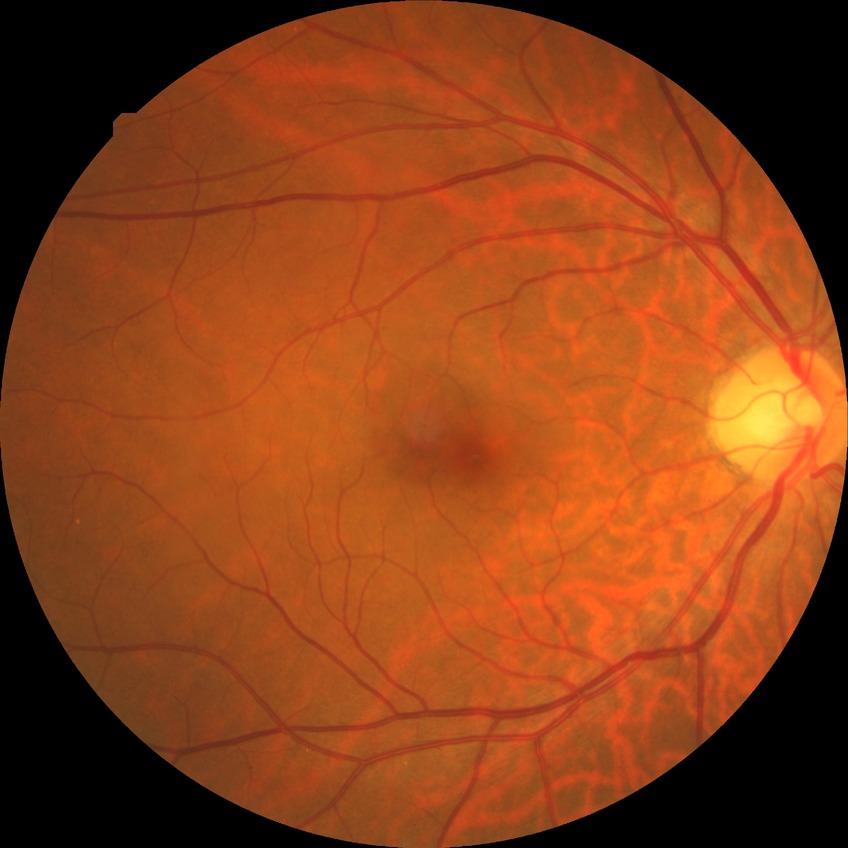

Retinopathy stage is no diabetic retinopathy.